FOV: 45 degrees; 2352 by 1568 pixels
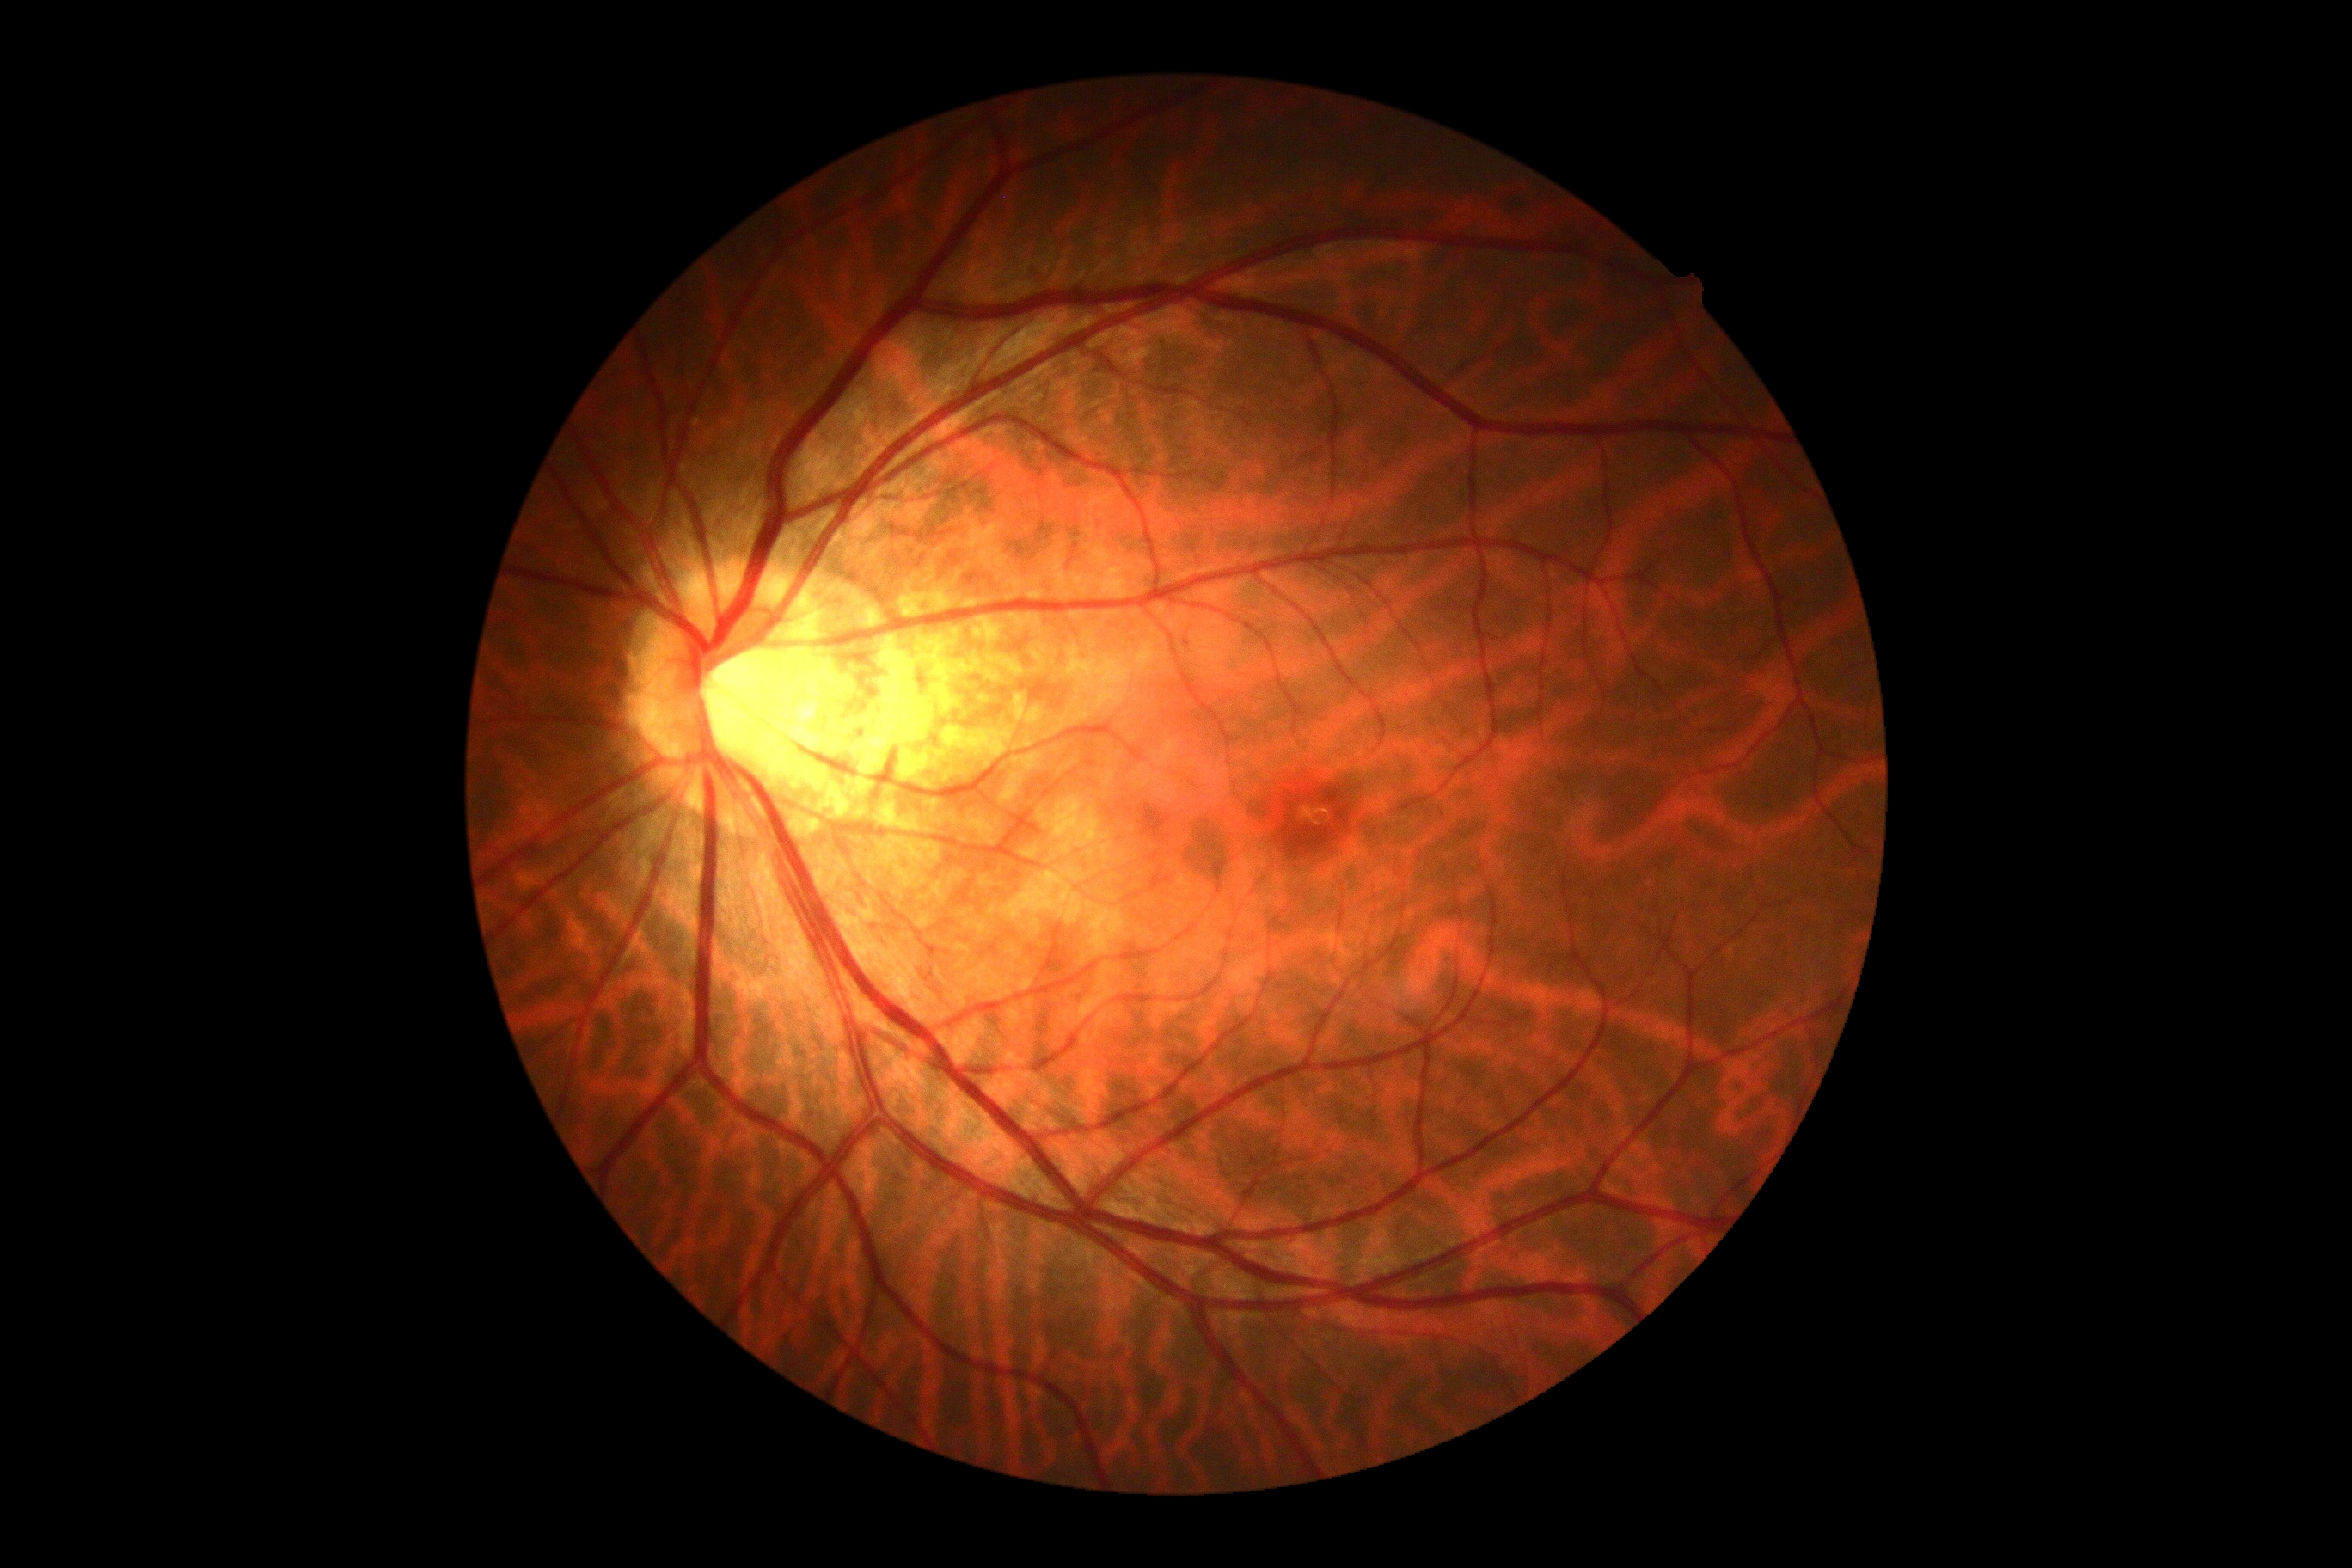 Diabetic retinopathy (DR) is grade 0.
No apparent diabetic retinopathy.